Color fundus image — 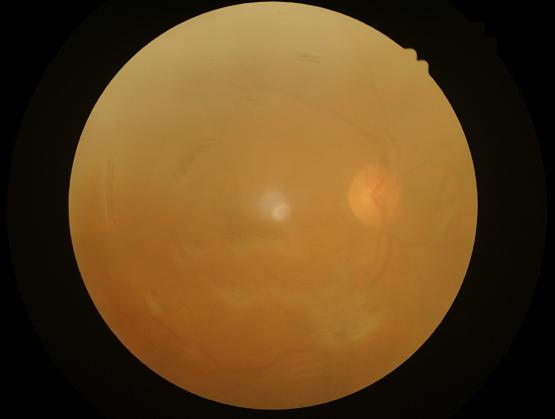

Narrow intensity range; structures are hard to distinguish. There is over- or under-exposure or a color cast. Image quality is inadequate for diagnostic use. Reduced sharpness with visible blur.